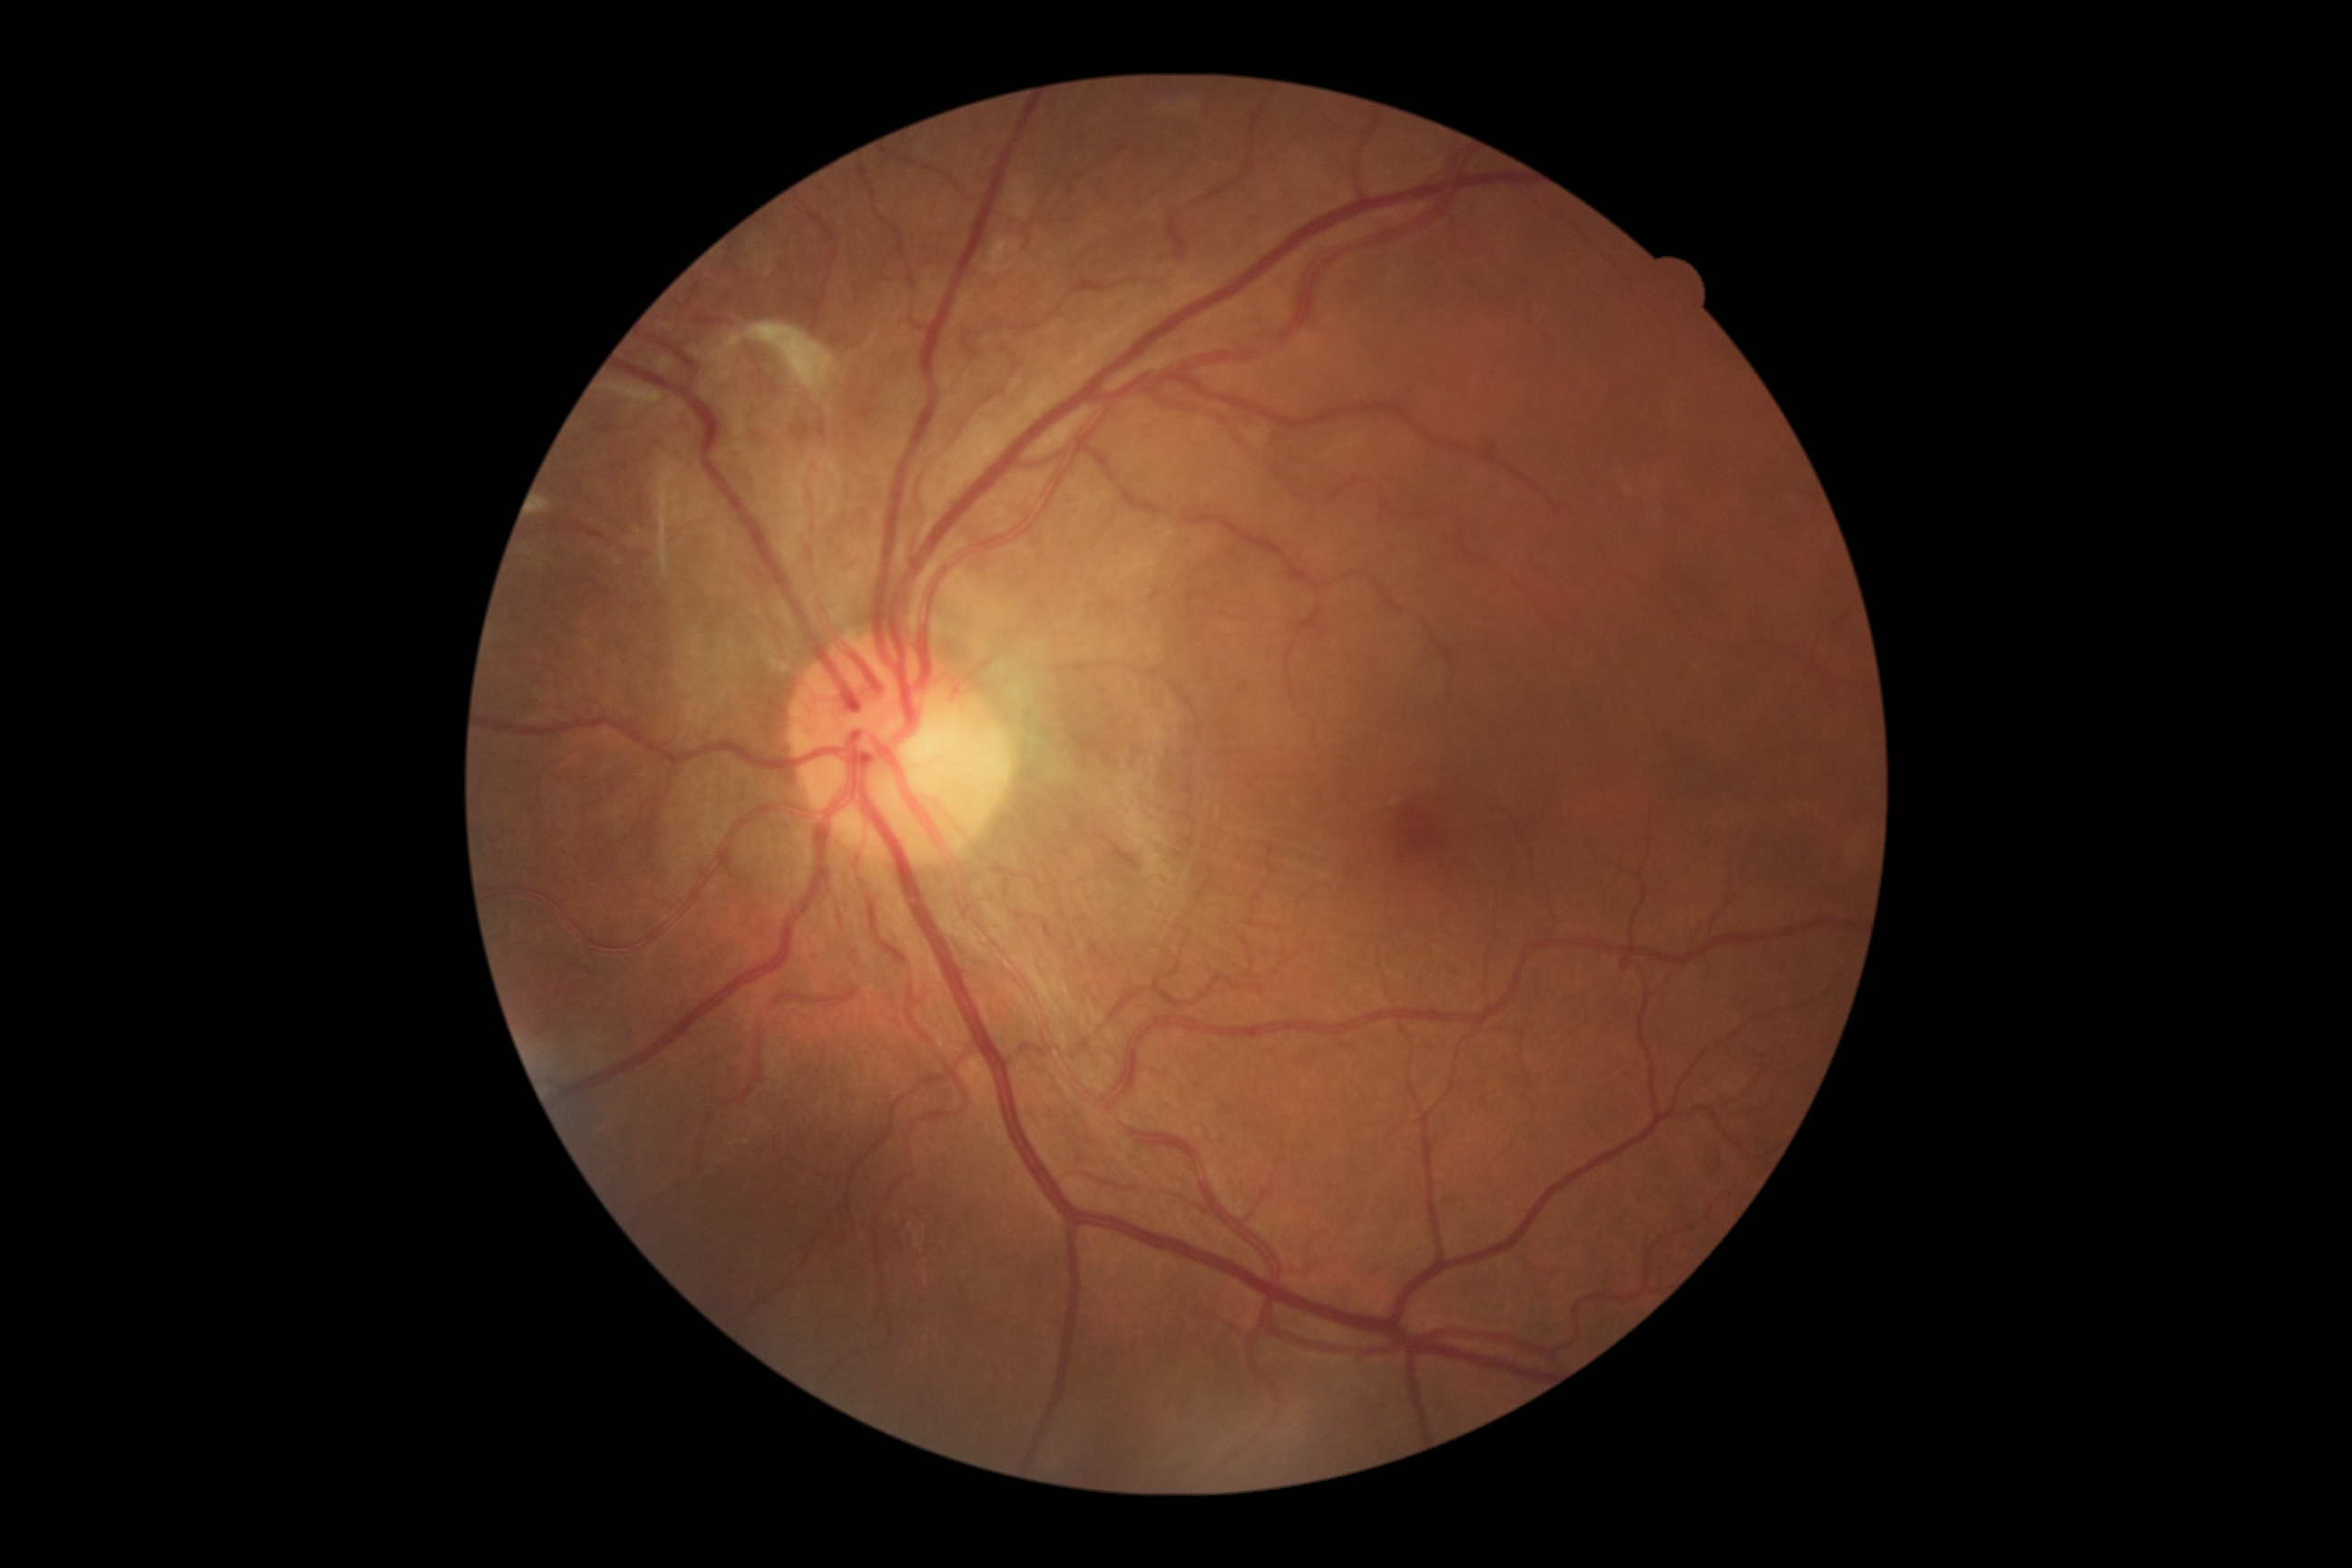

diabetic retinopathy (DR) = grade 4 (PDR).